2352 x 1568 pixels, retinal fundus photograph, FOV: 45 degrees: 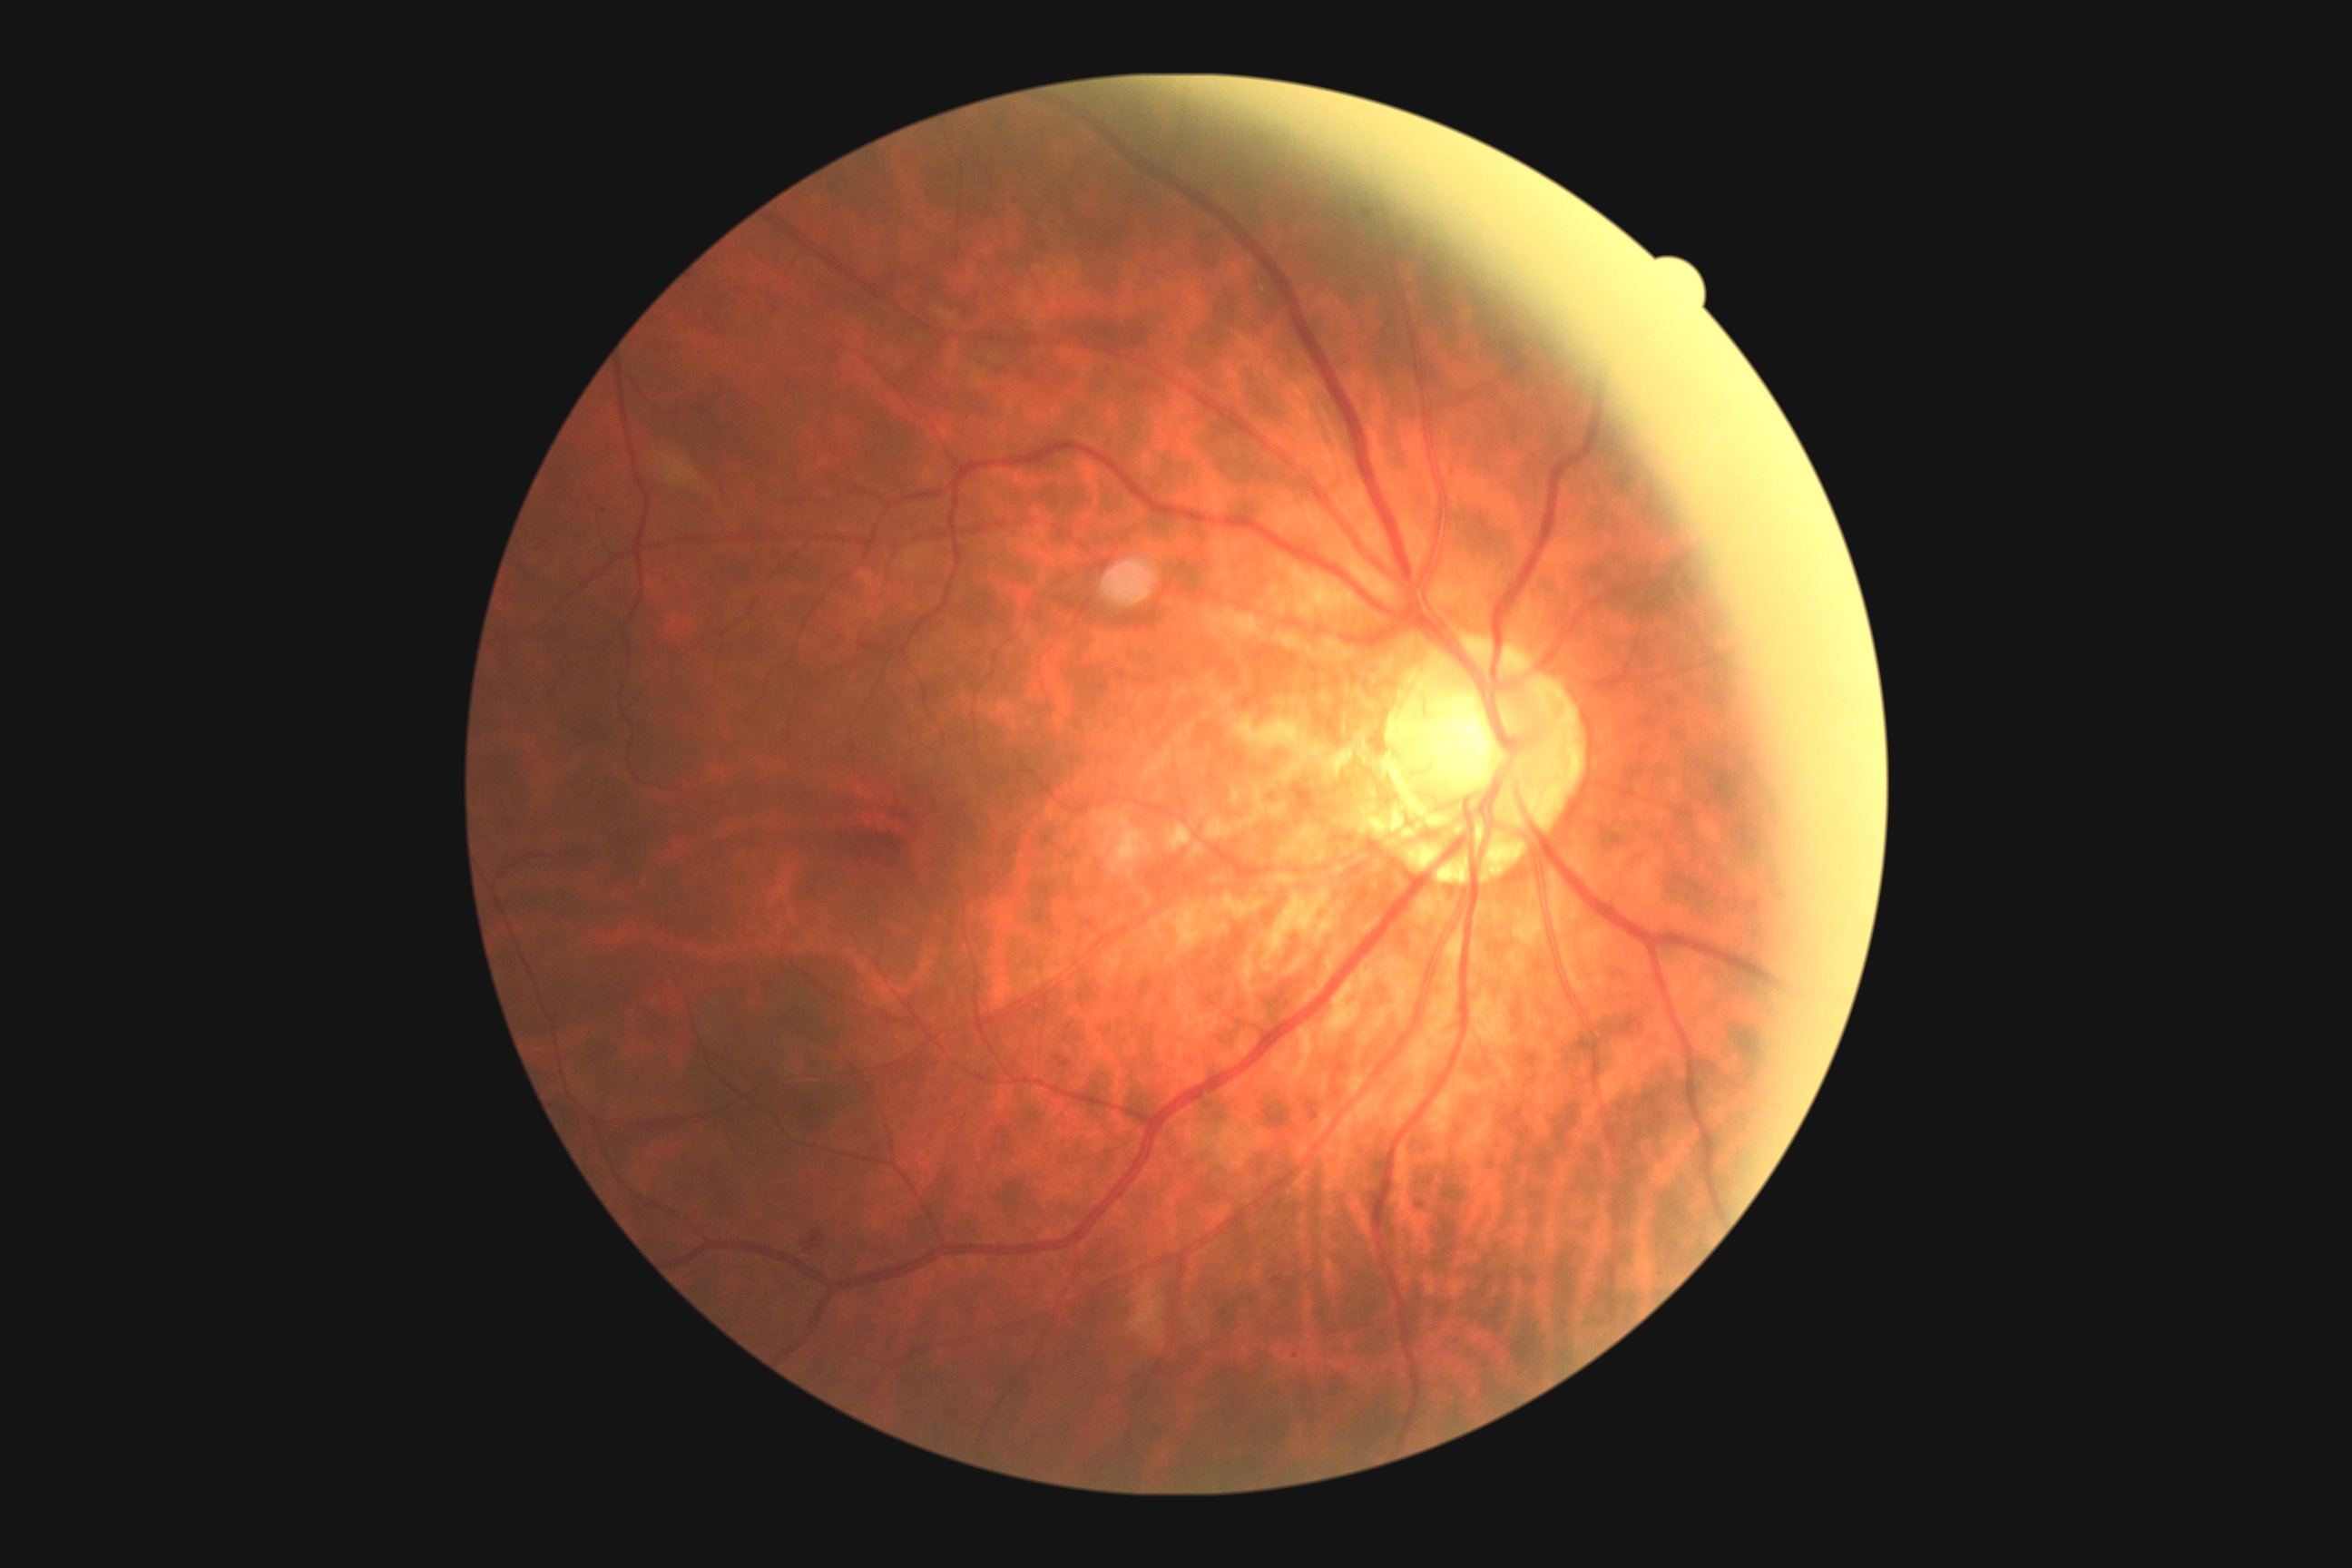

Disease class: non-proliferative diabetic retinopathy.
Retinopathy grade is moderate non-proliferative diabetic retinopathy (2).